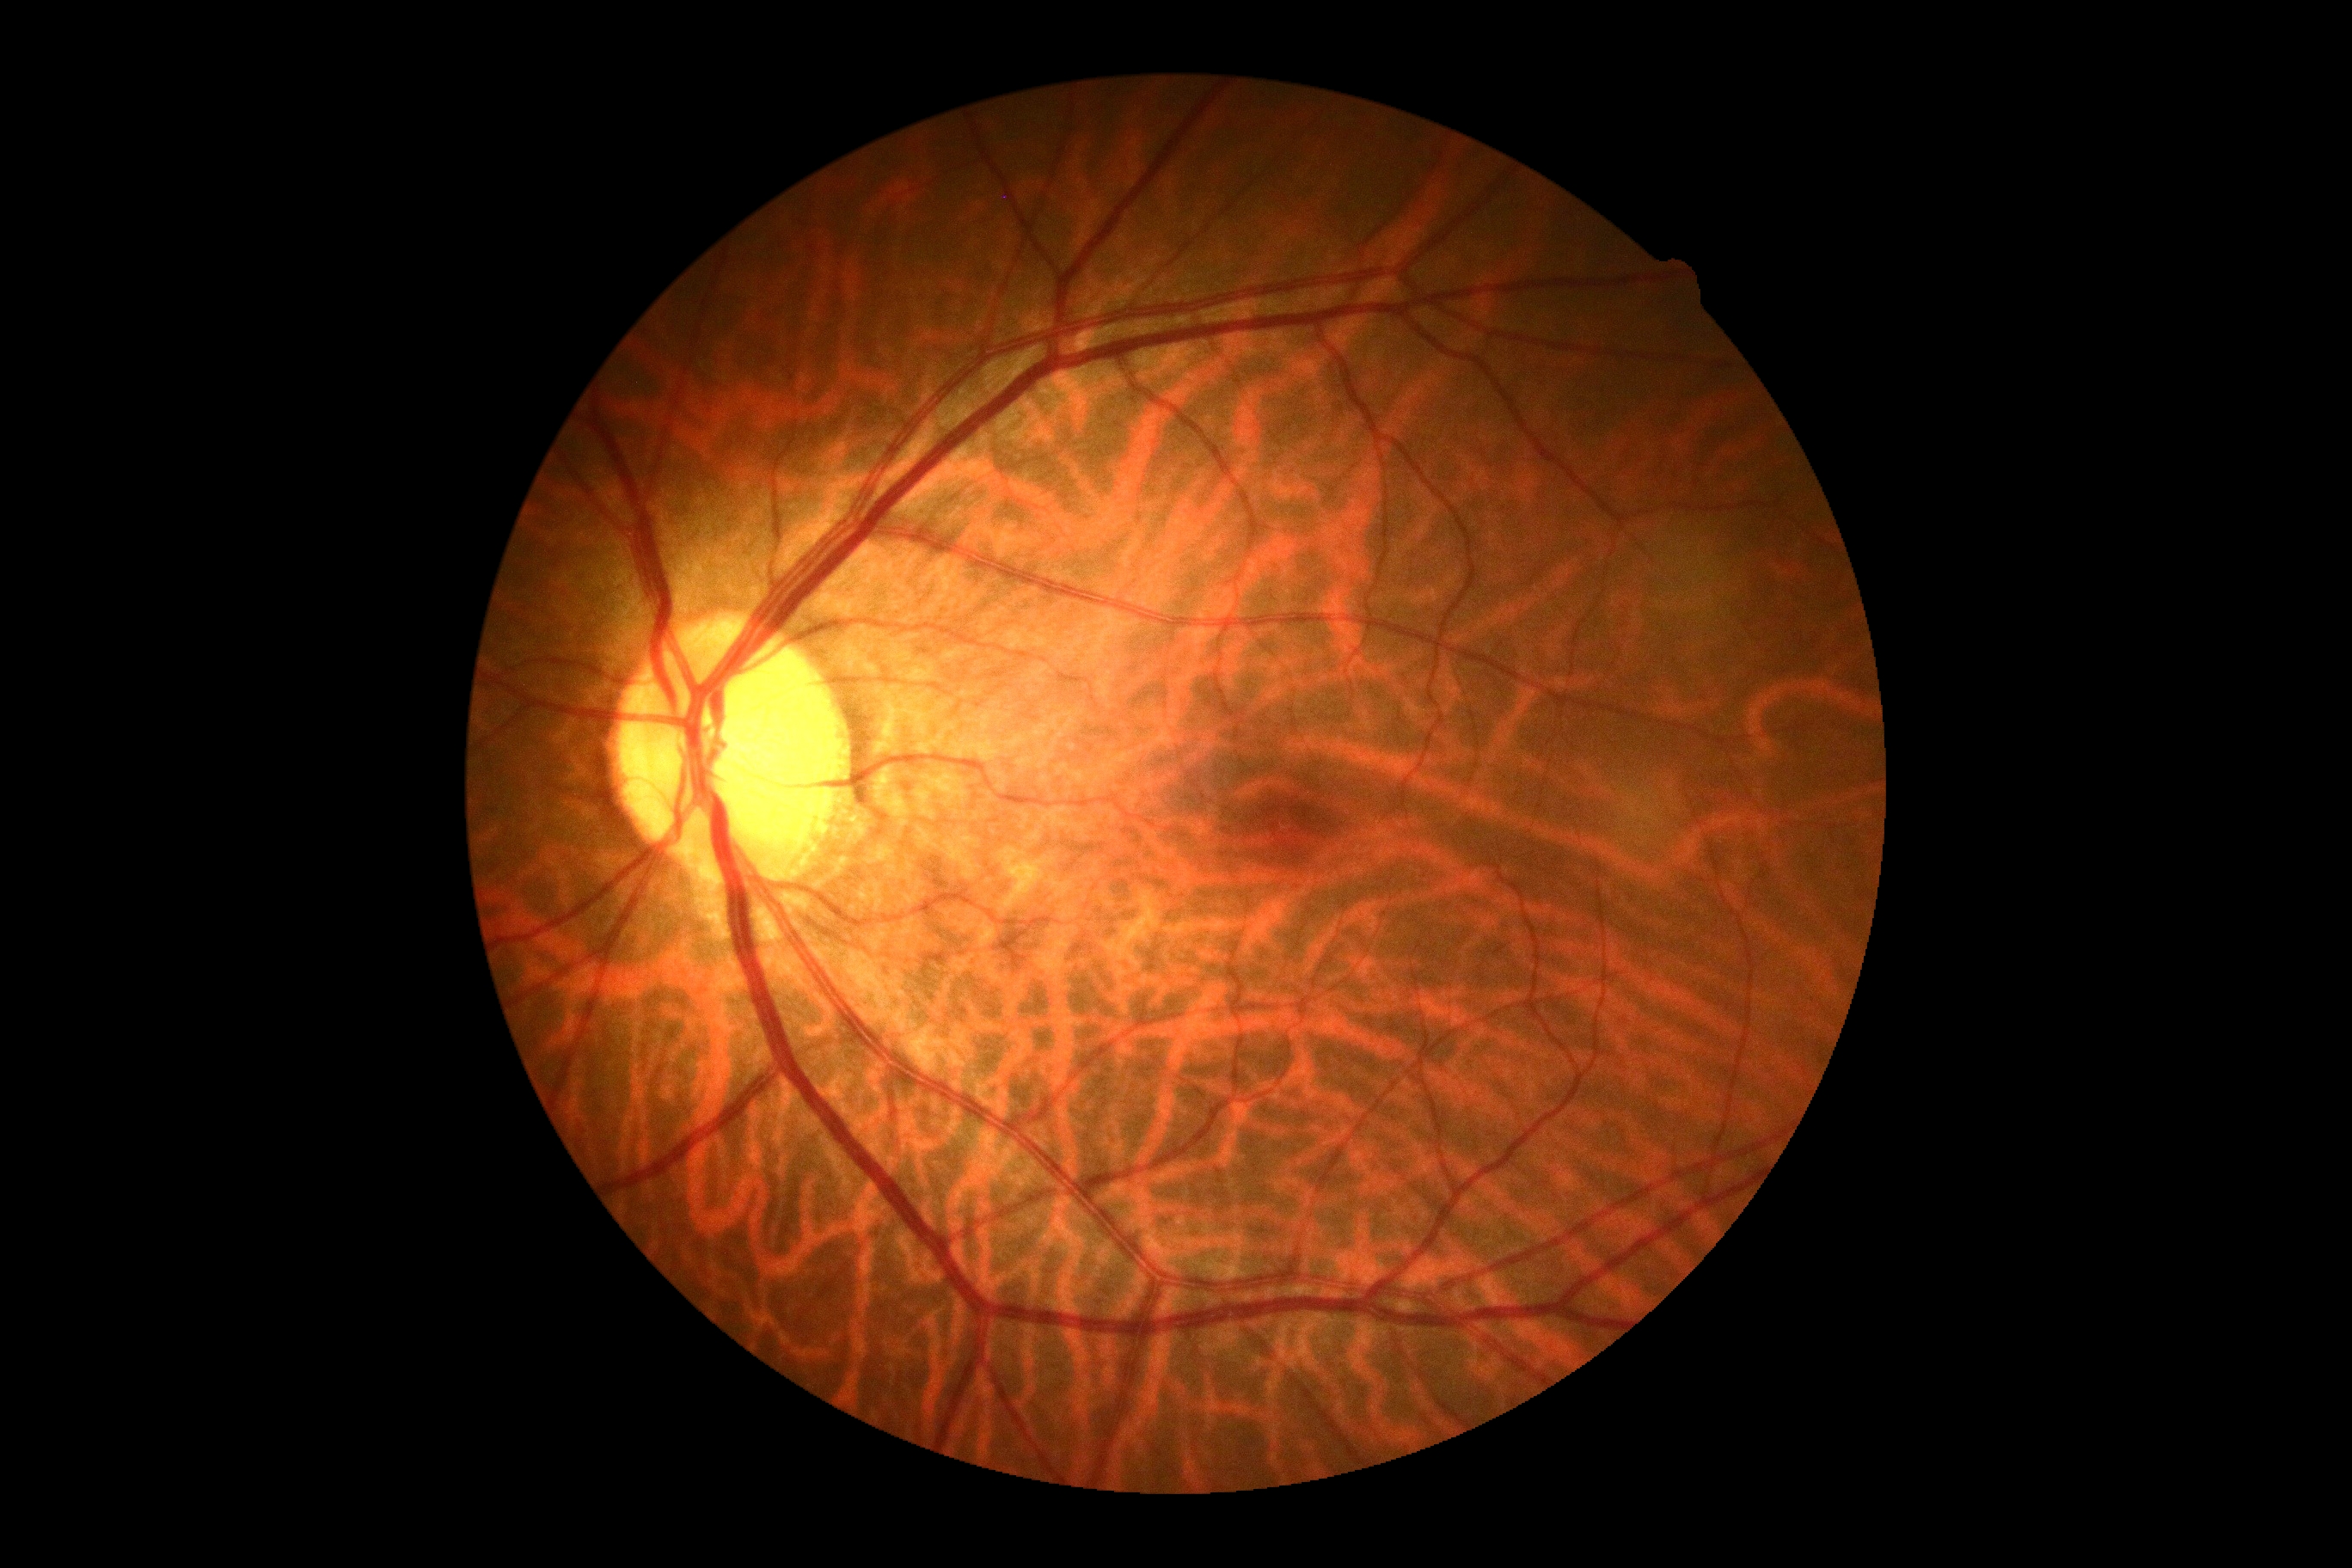

DR impression@no signs of DR, DR grade@0 (no apparent retinopathy).